Acquired on the Clarity RetCam 3; infant wide-field fundus photograph:
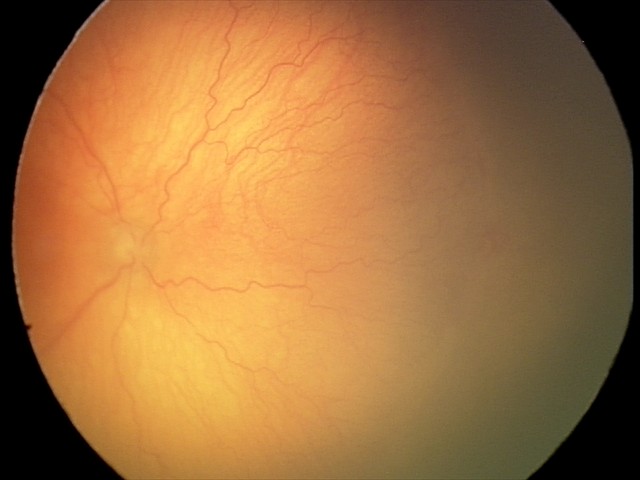 Plus disease was diagnosed. Diagnosis from this screening exam: aggressive retinopathy of prematurity — rapidly progressive severe ROP with prominent plus disease, often without classic stage progression.